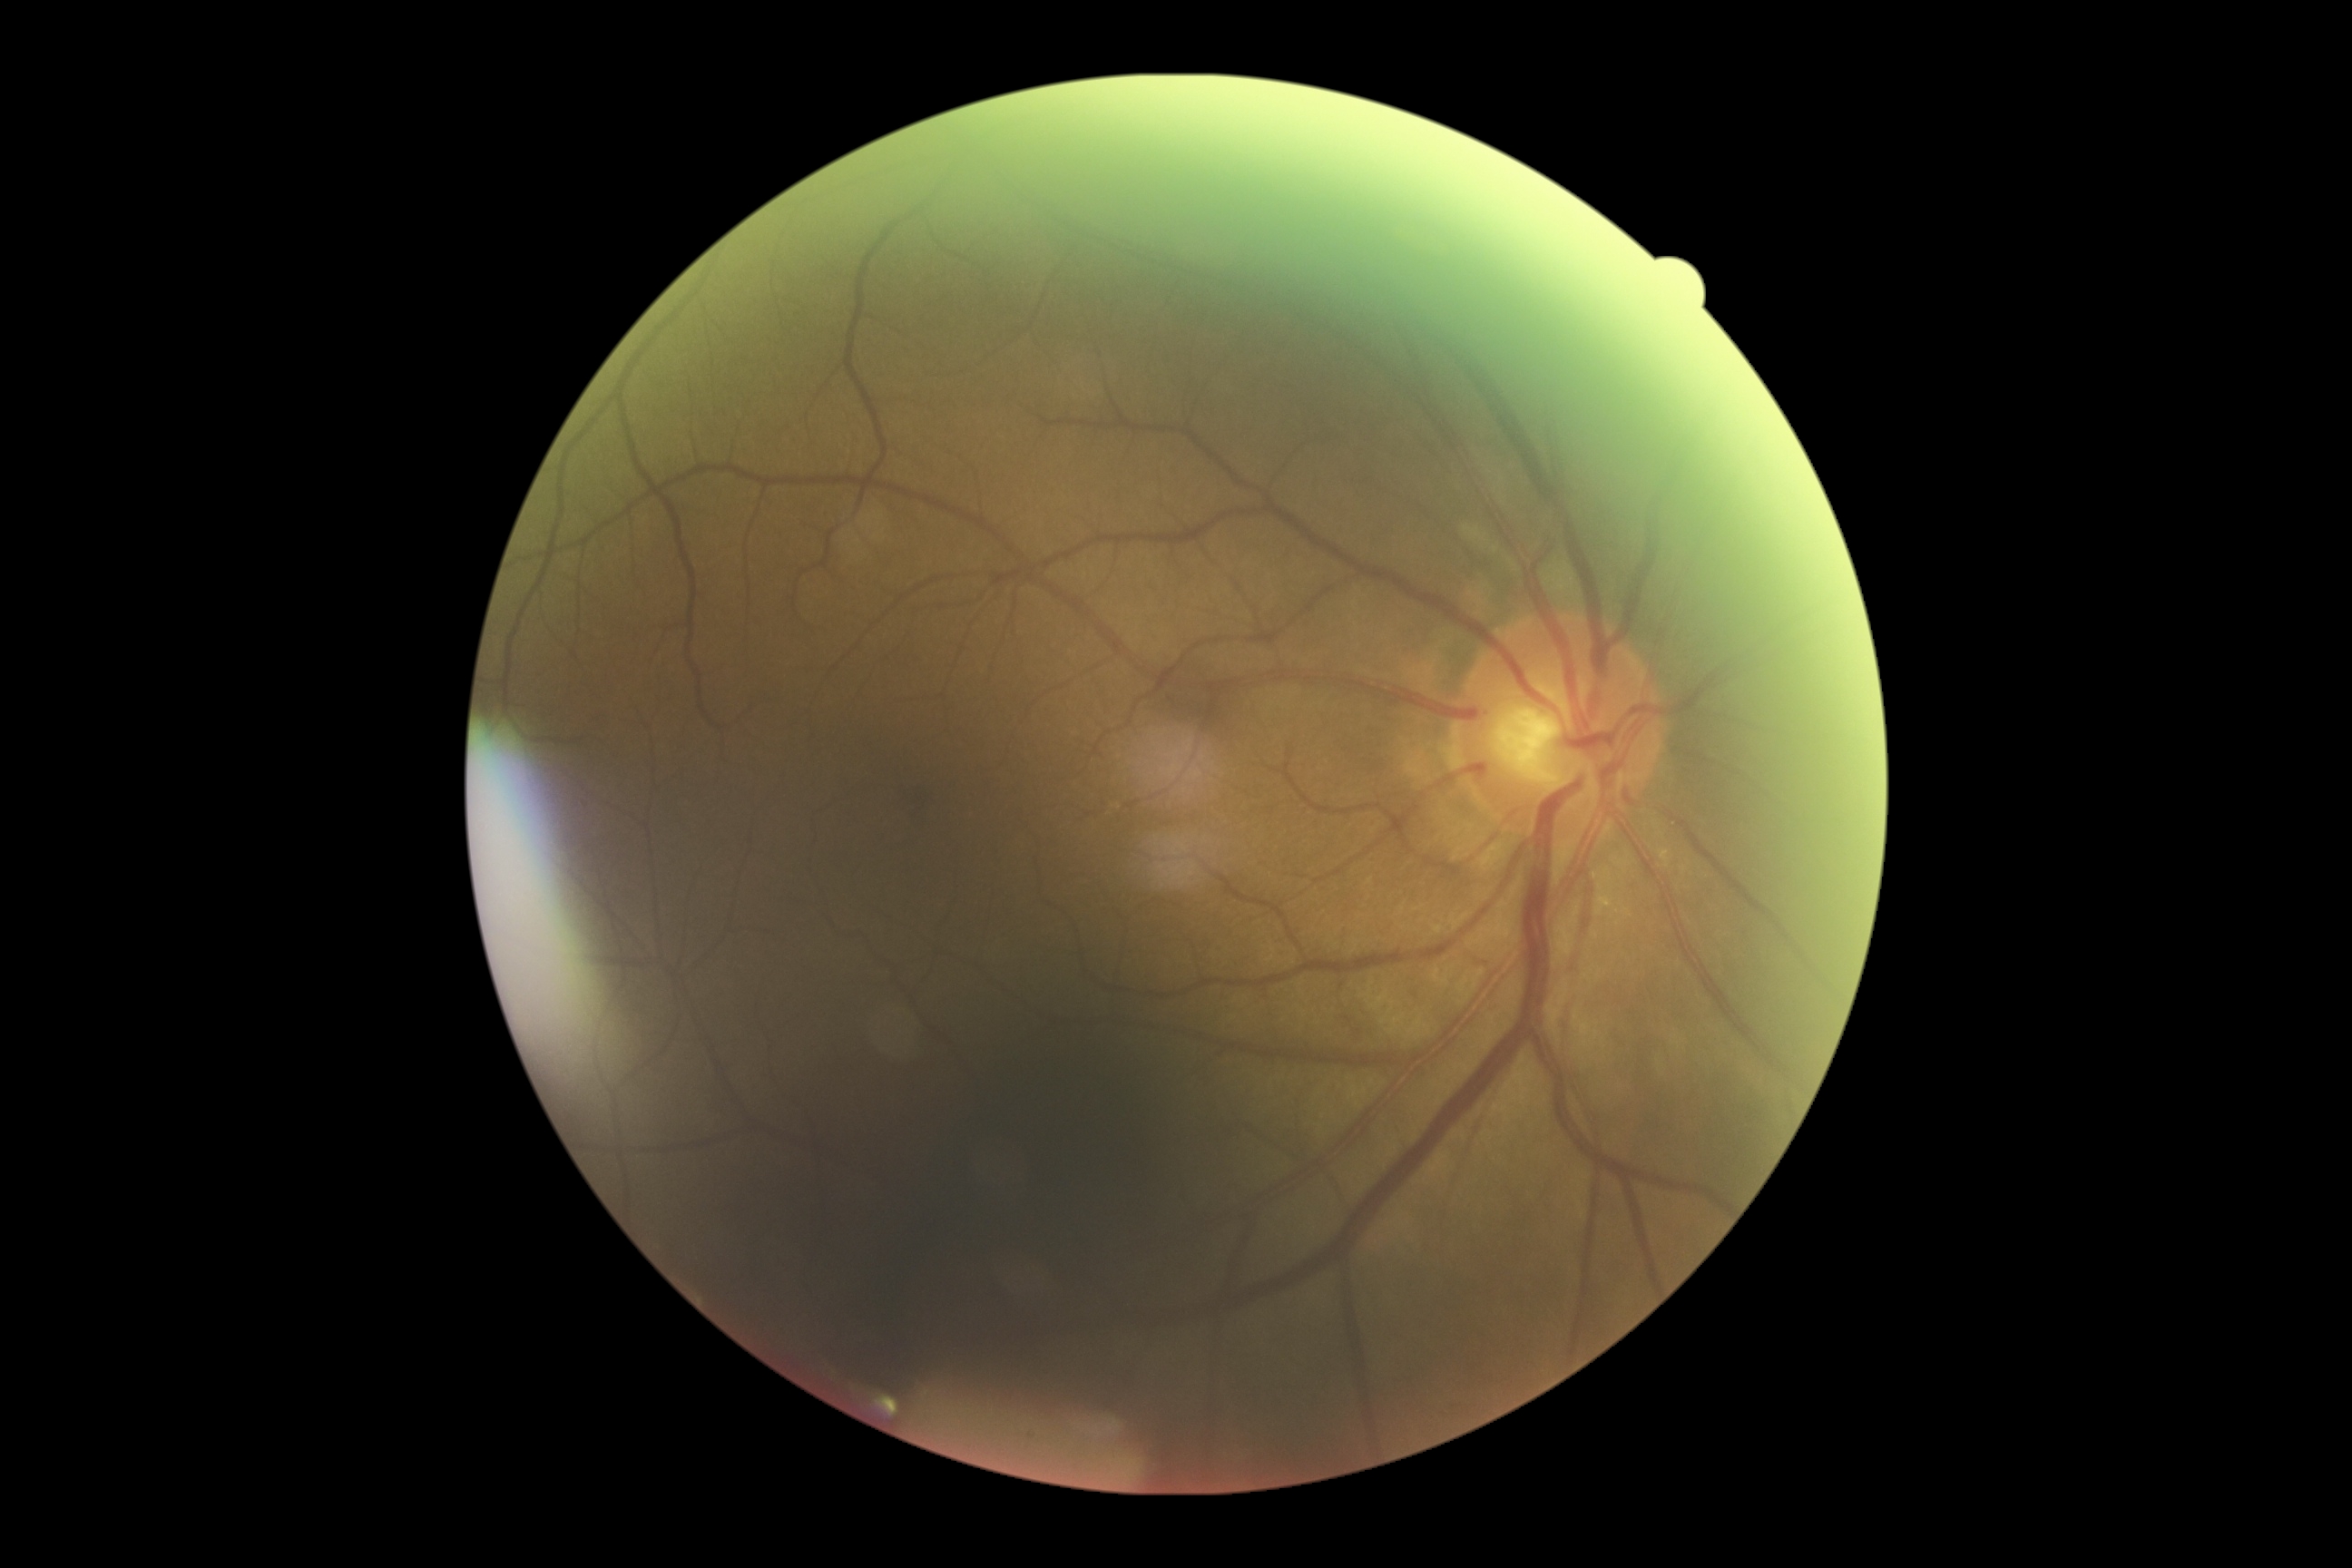
diabetic retinopathy (DR): 0.